640x480px; captured with the Clarity RetCam 3 (130° field of view); pediatric retinal photograph (wide-field).
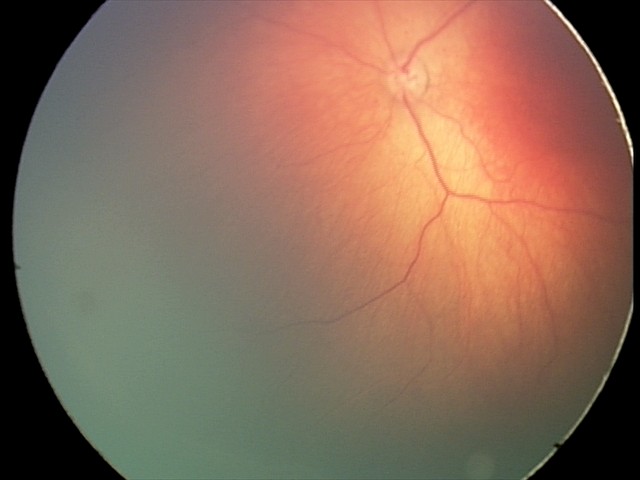 Q: What was the screening finding?
A: ROP stage 2 — ridge with height and width at the demarcation line